45-degree field of view; color fundus photograph — 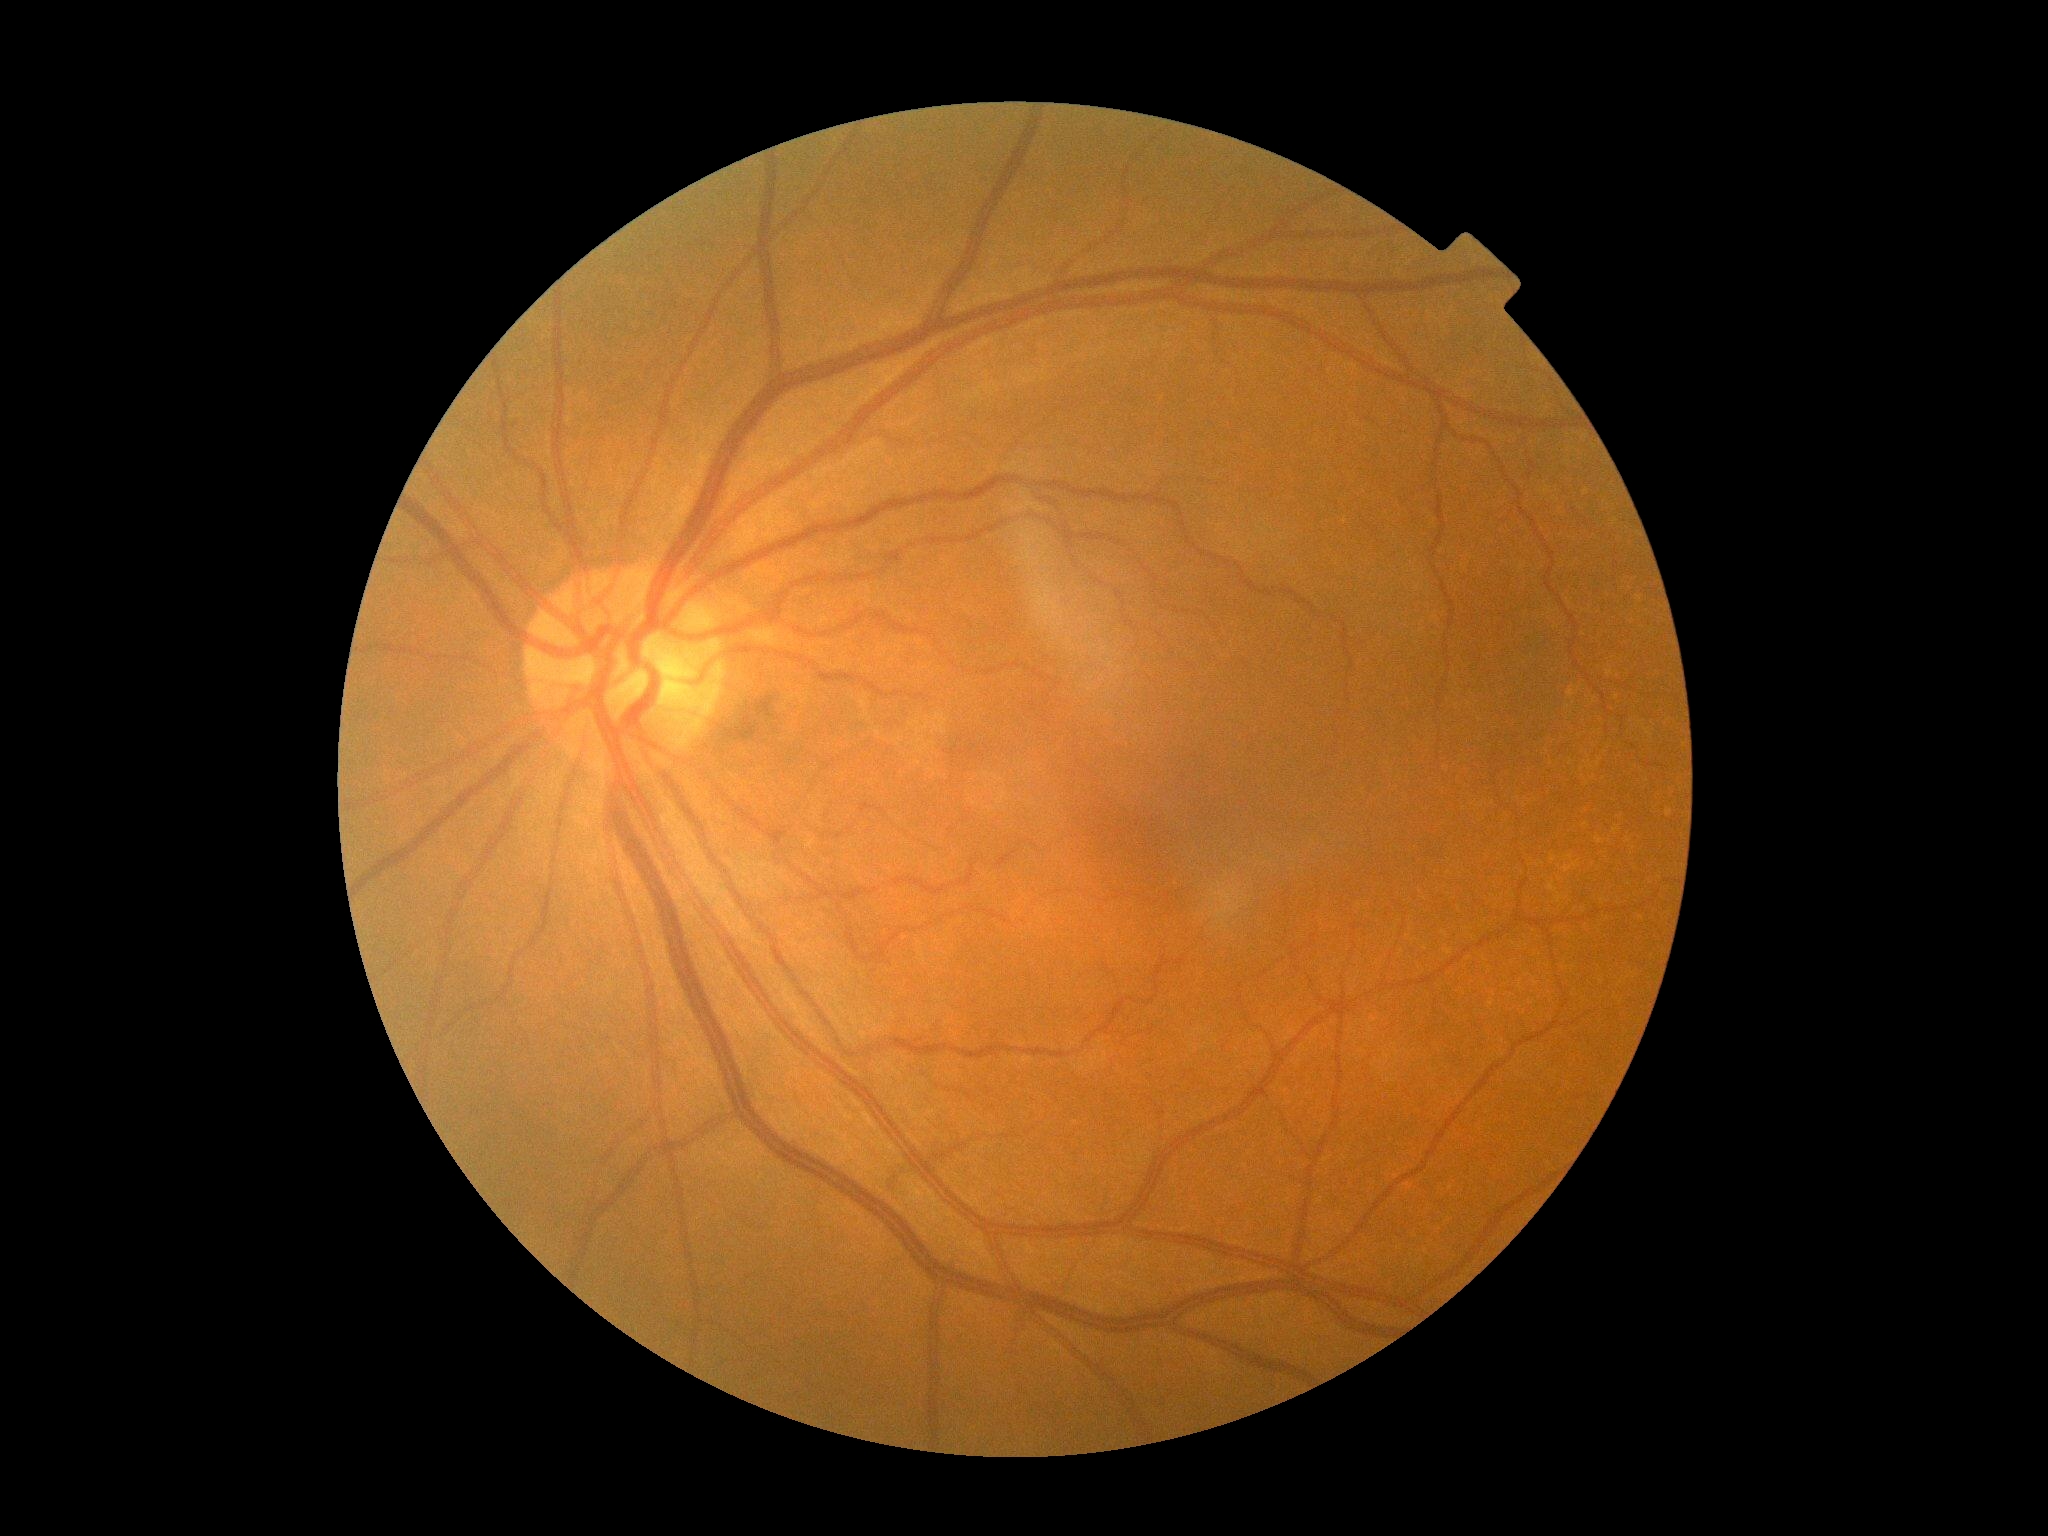

Diabetic retinopathy (DR) is grade 0 (no apparent retinopathy).